Captured with the Clarity RetCam 3 (130° field of view). Infant wide-field retinal image: 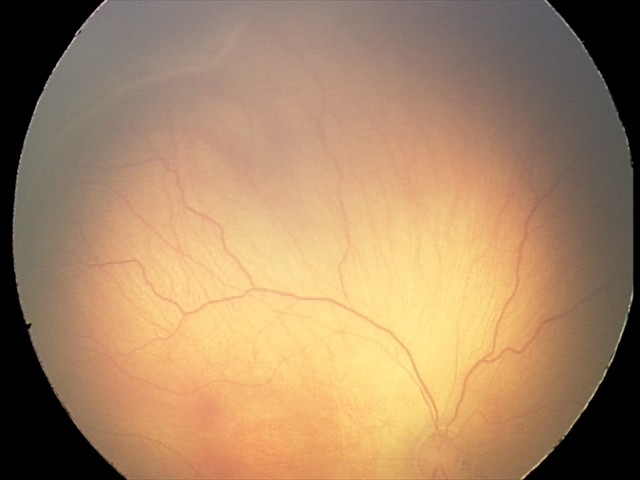 No plus disease. From an examination with diagnosis of retinopathy of prematurity (ROP) stage 2 — ridge with height and width at the demarcation line.